640x480px. Pediatric retinal photograph (wide-field) — 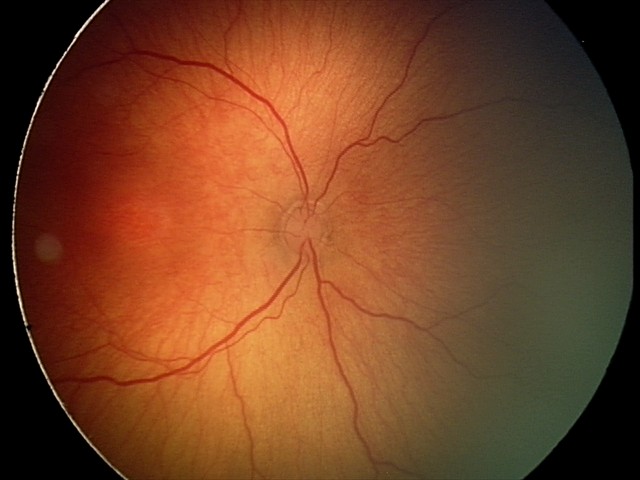 No plus disease.
Examination diagnosed as ROP stage 2.